Camera: NIDEK AFC-230:
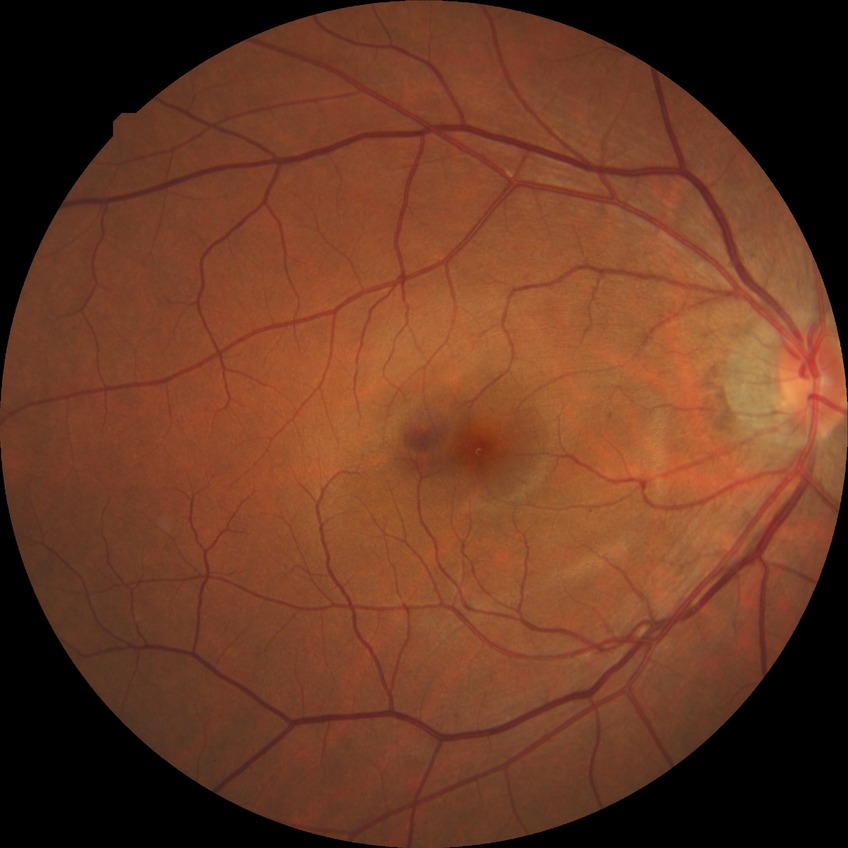 Findings:
• diabetic retinopathy (DR) — SDR (simple diabetic retinopathy)